Captured with the Natus RetCam Envision (130° field of view) · wide-field fundus image from infant ROP screening:
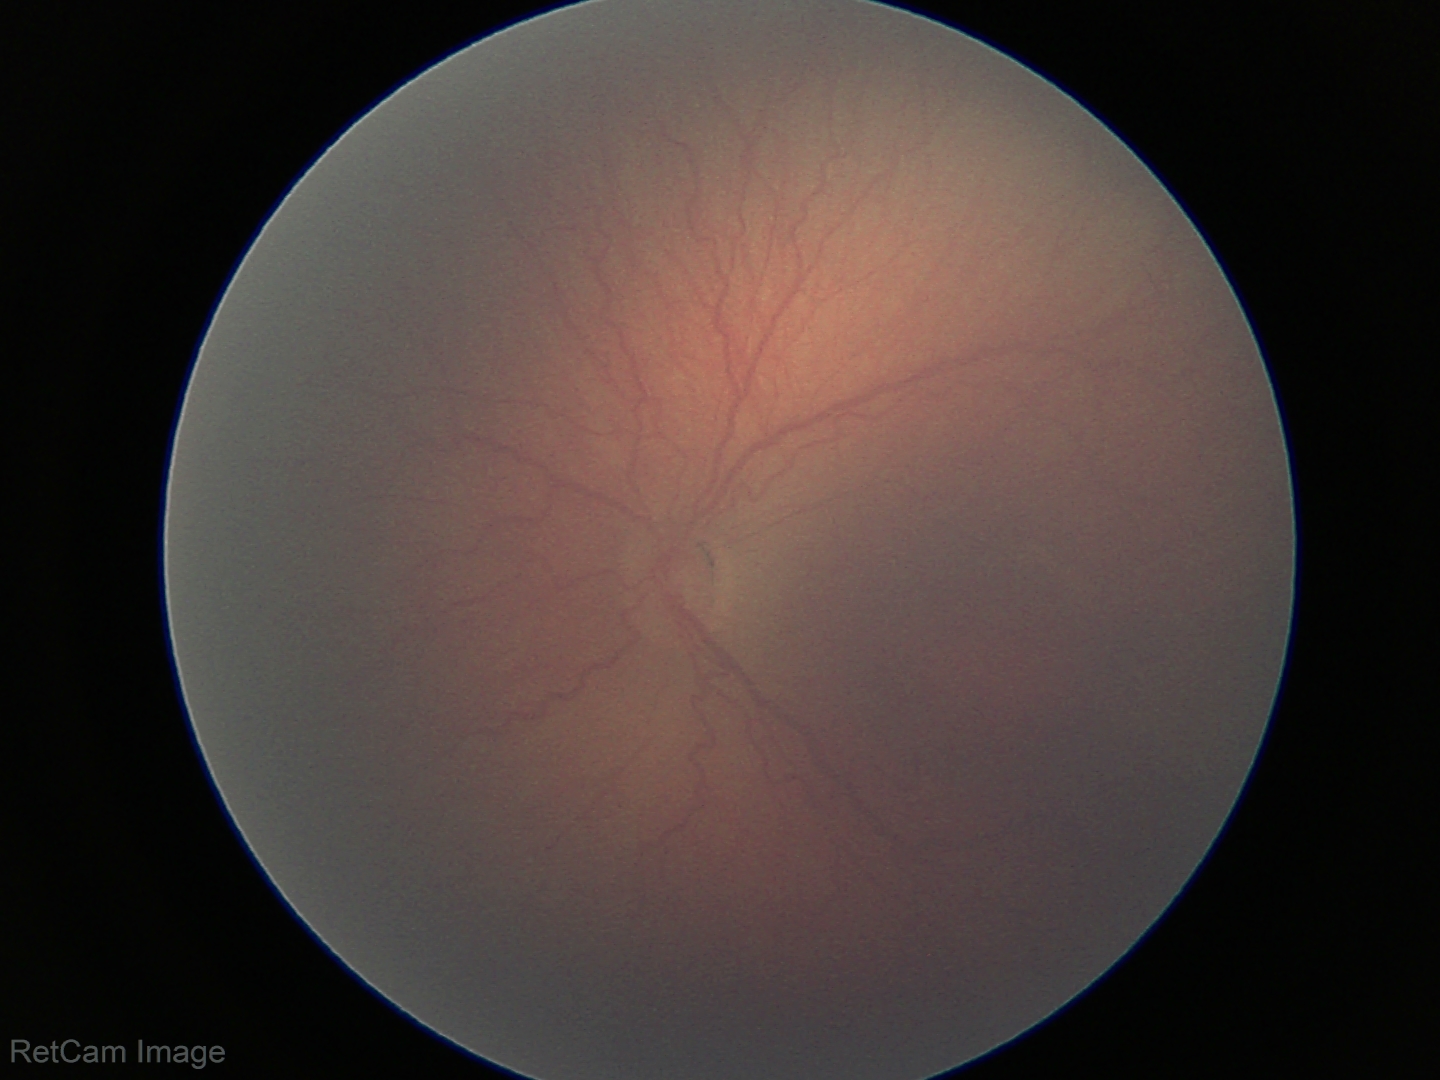

ROP stage: 2.